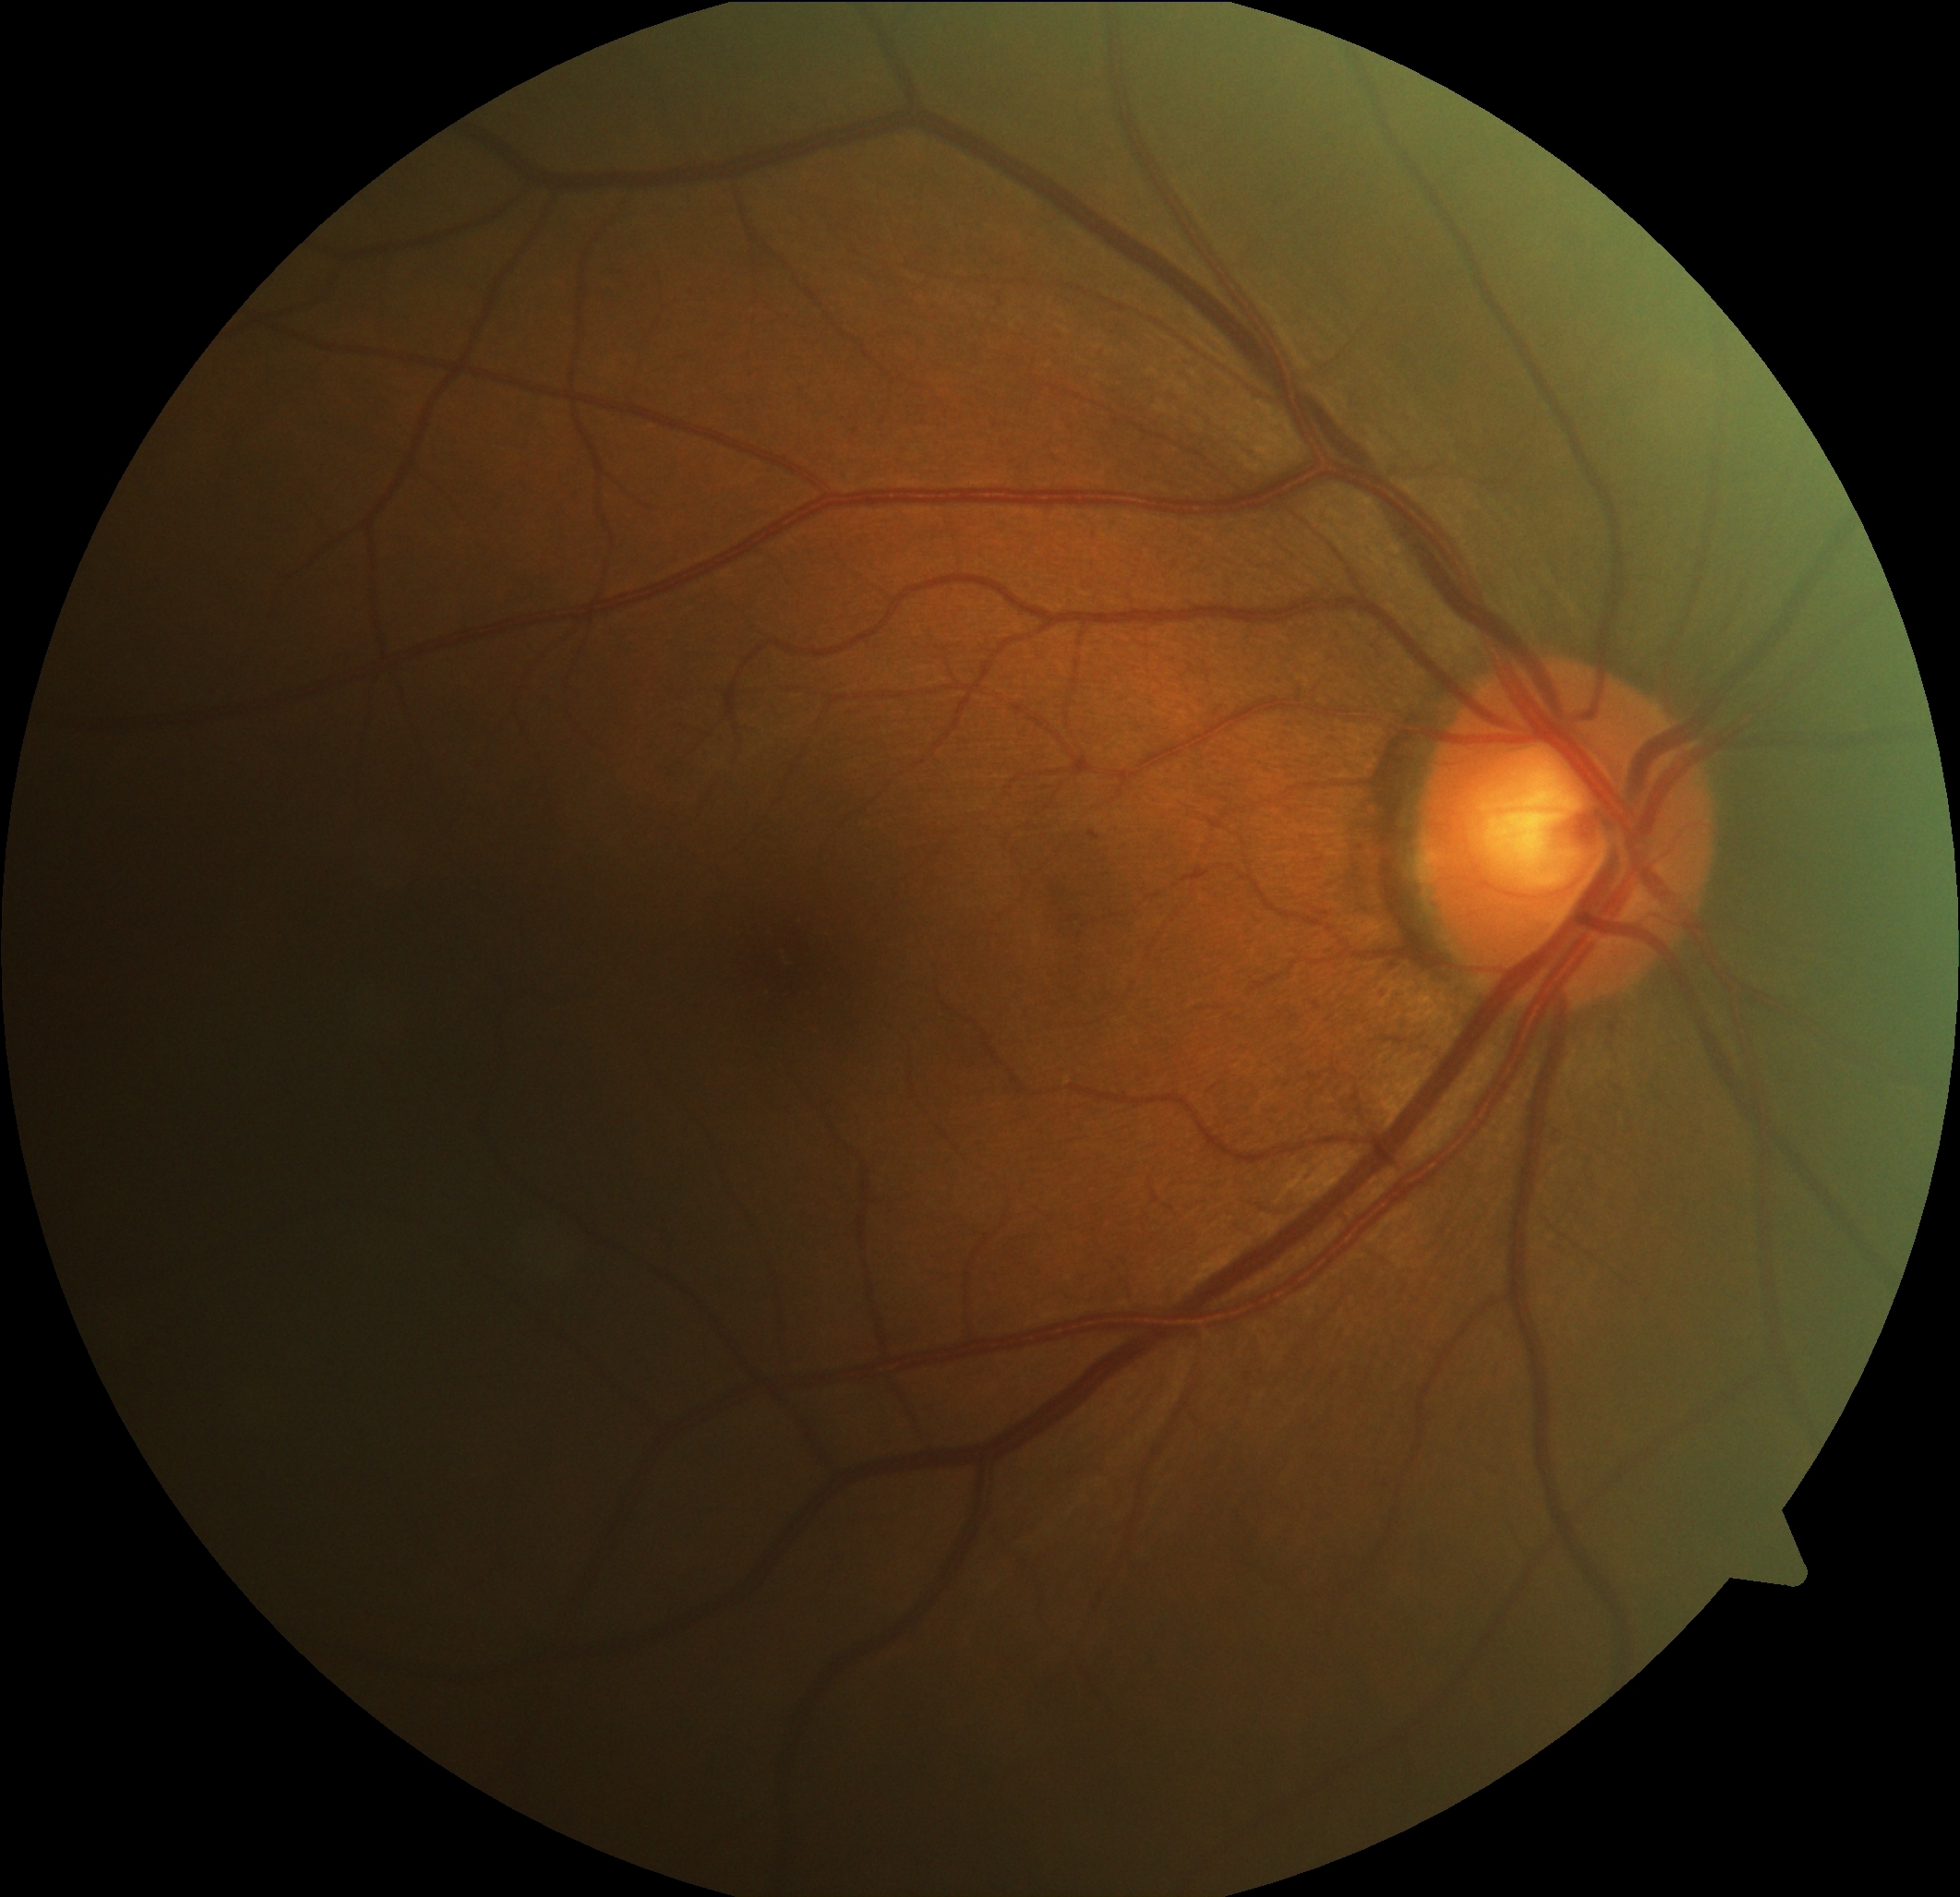

Diabetic retinopathy (DR): grade 1 (mild NPDR) — presence of microaneurysms only.